2352x1568px. 45° FOV: 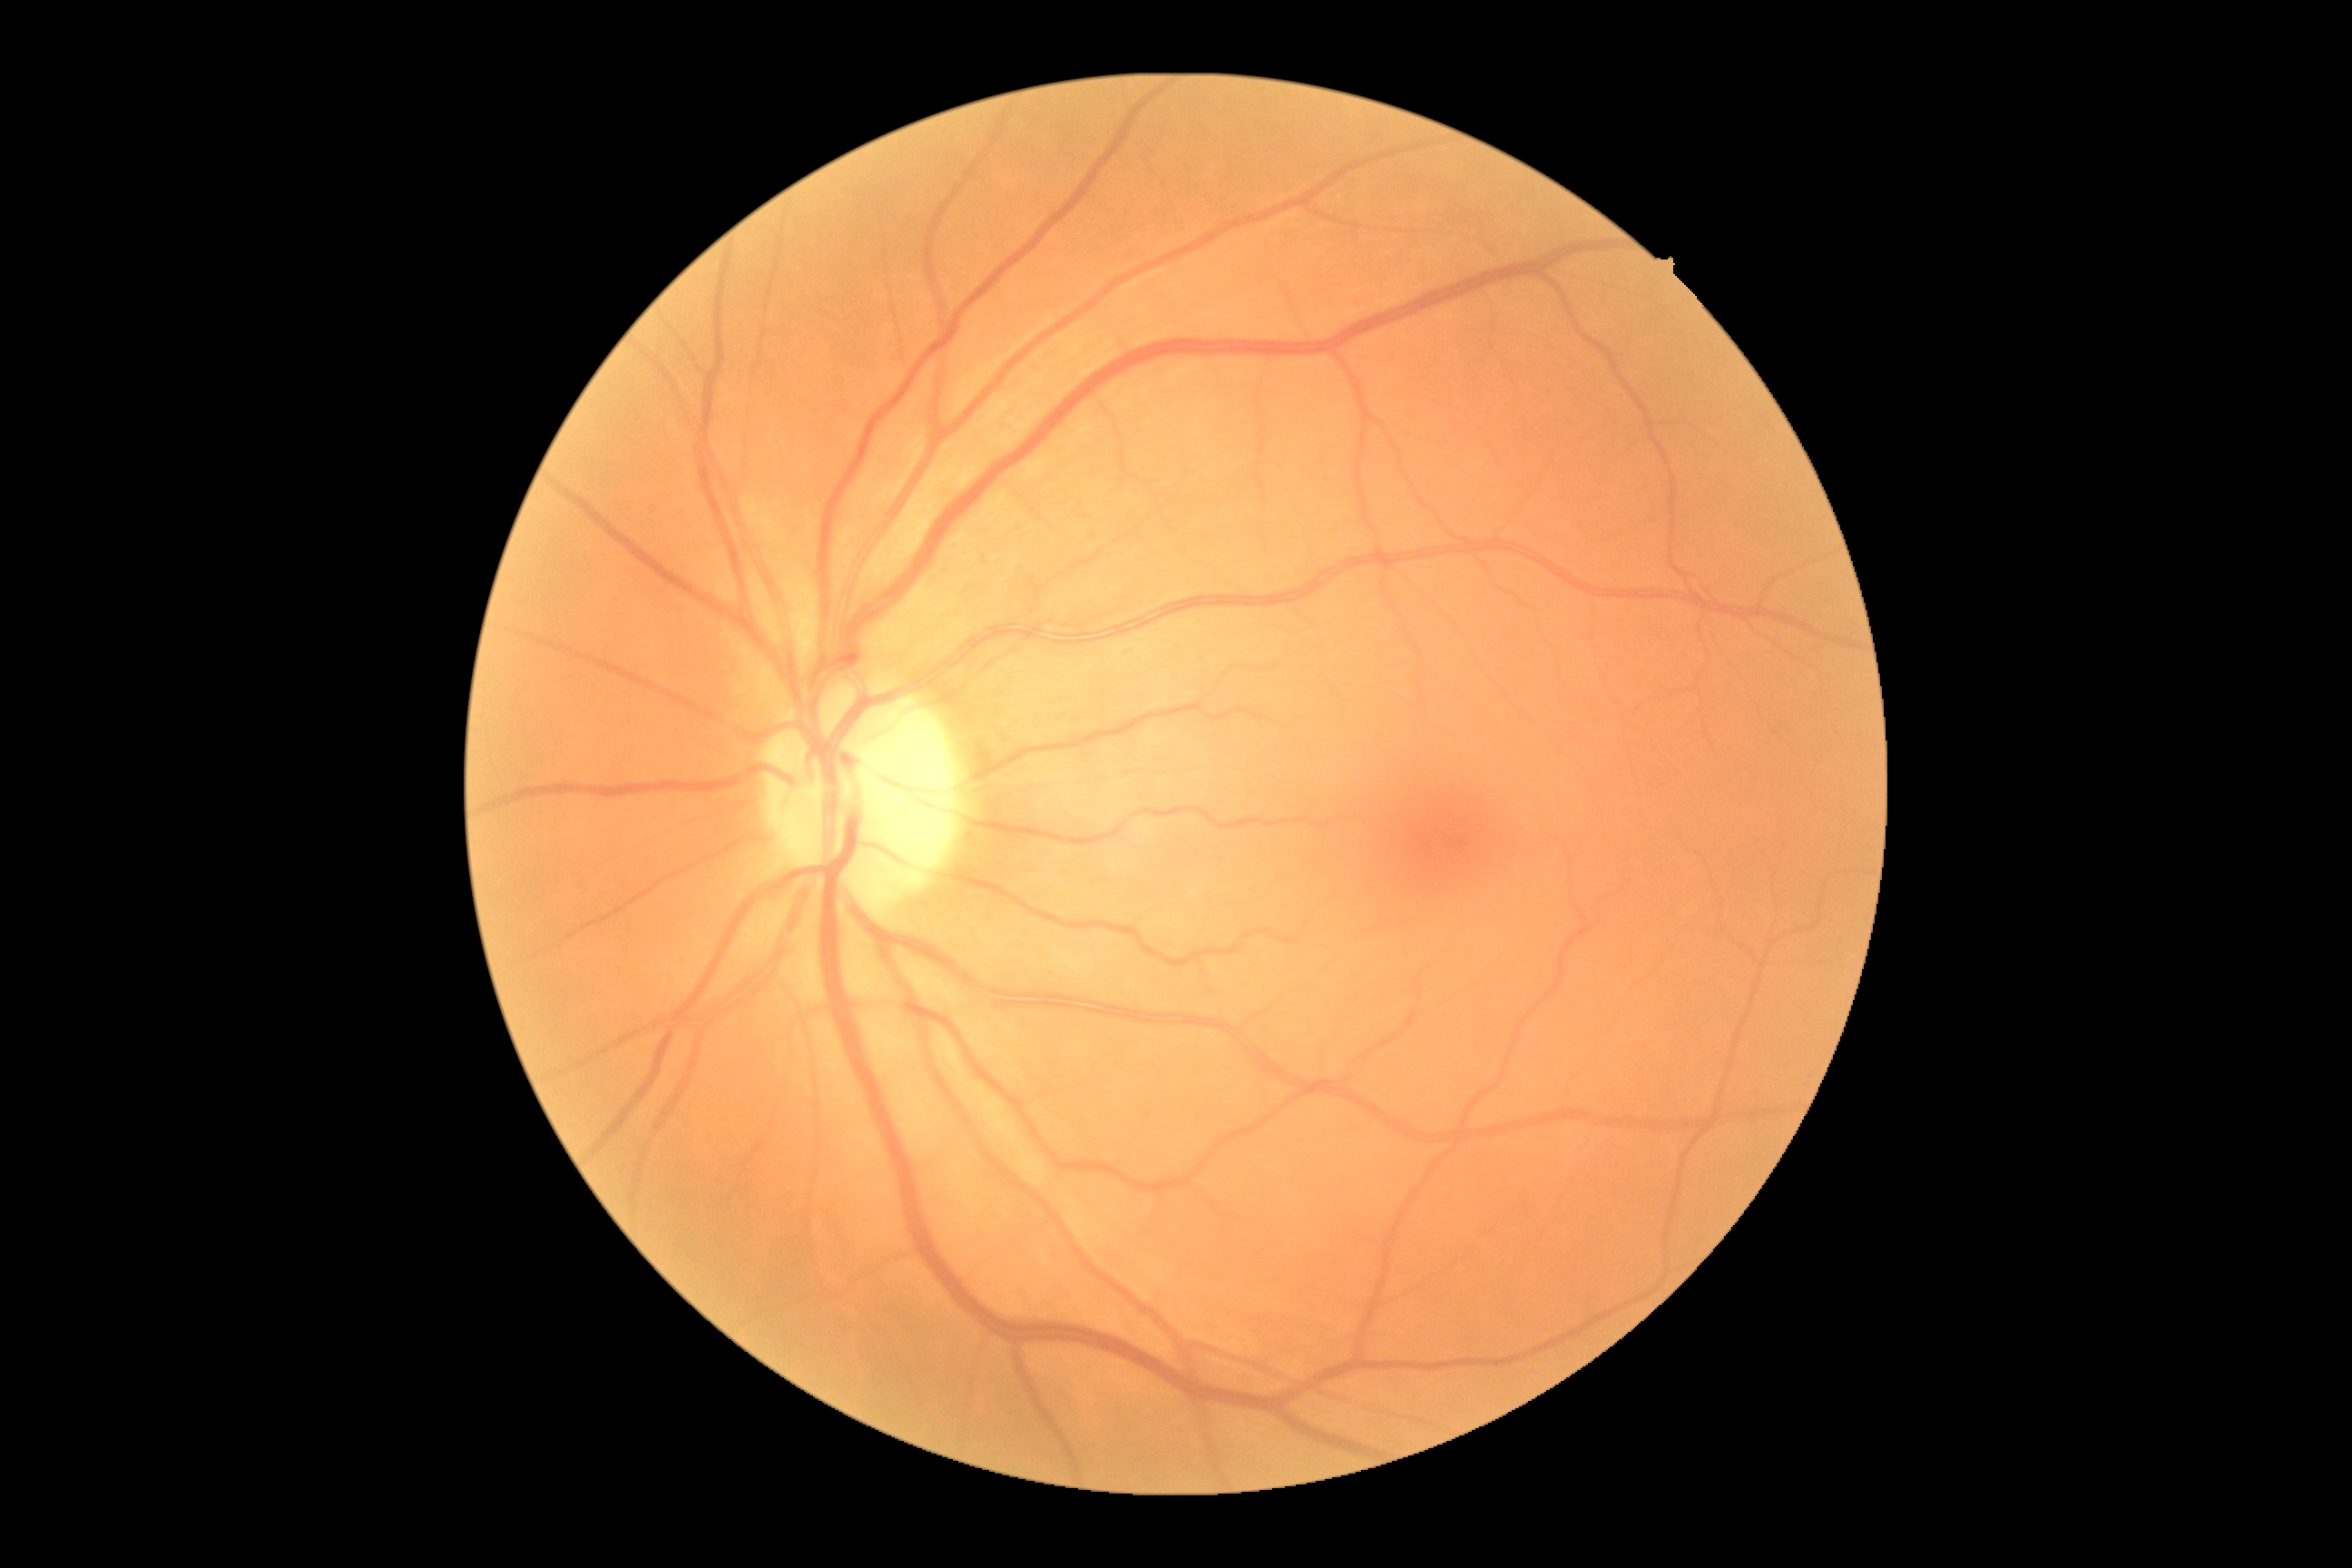
DR grade = 0 (no apparent retinopathy).